Modified Davis classification.
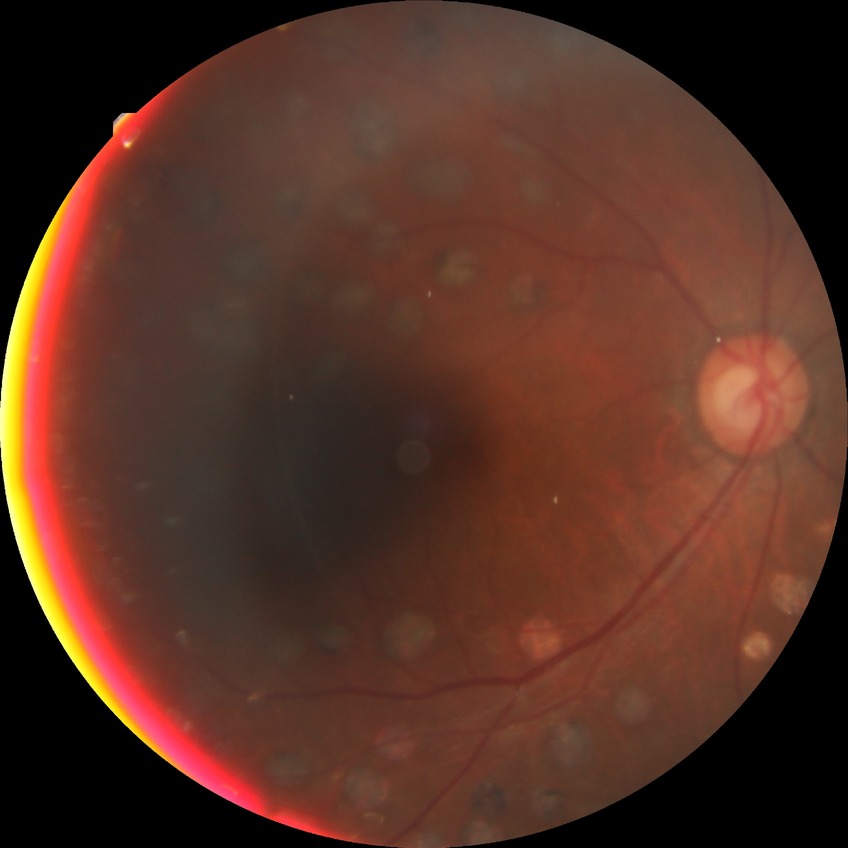
Retinopathy stage: proliferative diabetic retinopathy.